Captured with the Natus RetCam Envision (130° field of view); pediatric retinal photograph (wide-field).
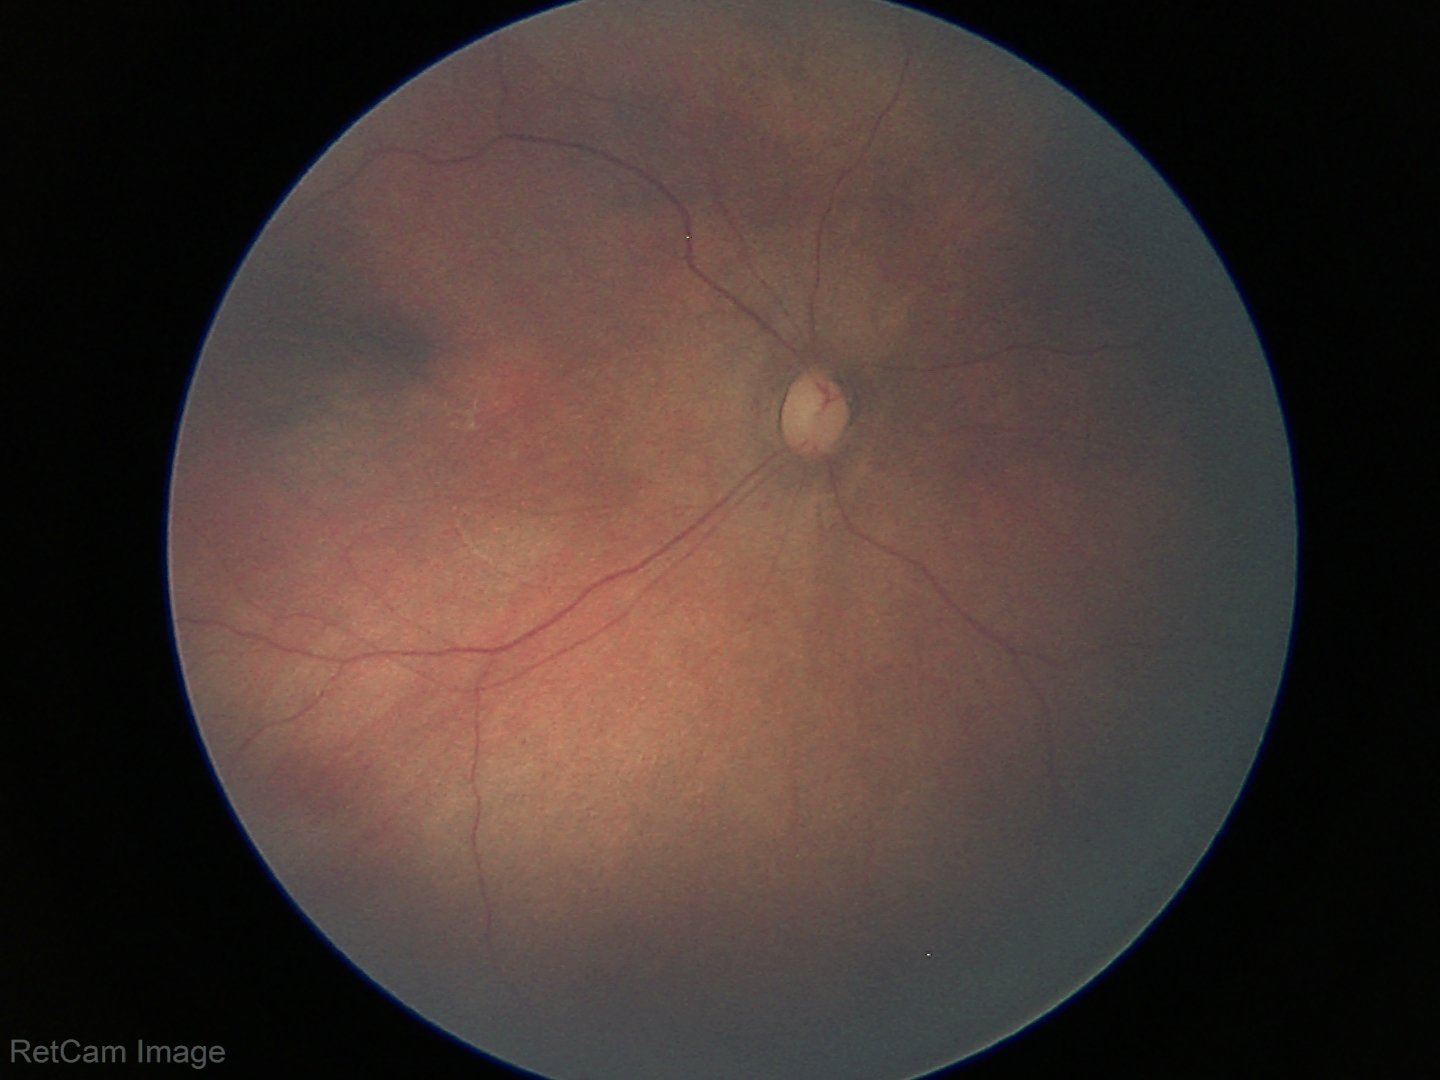

Screening examination with no abnormal retinal findings.